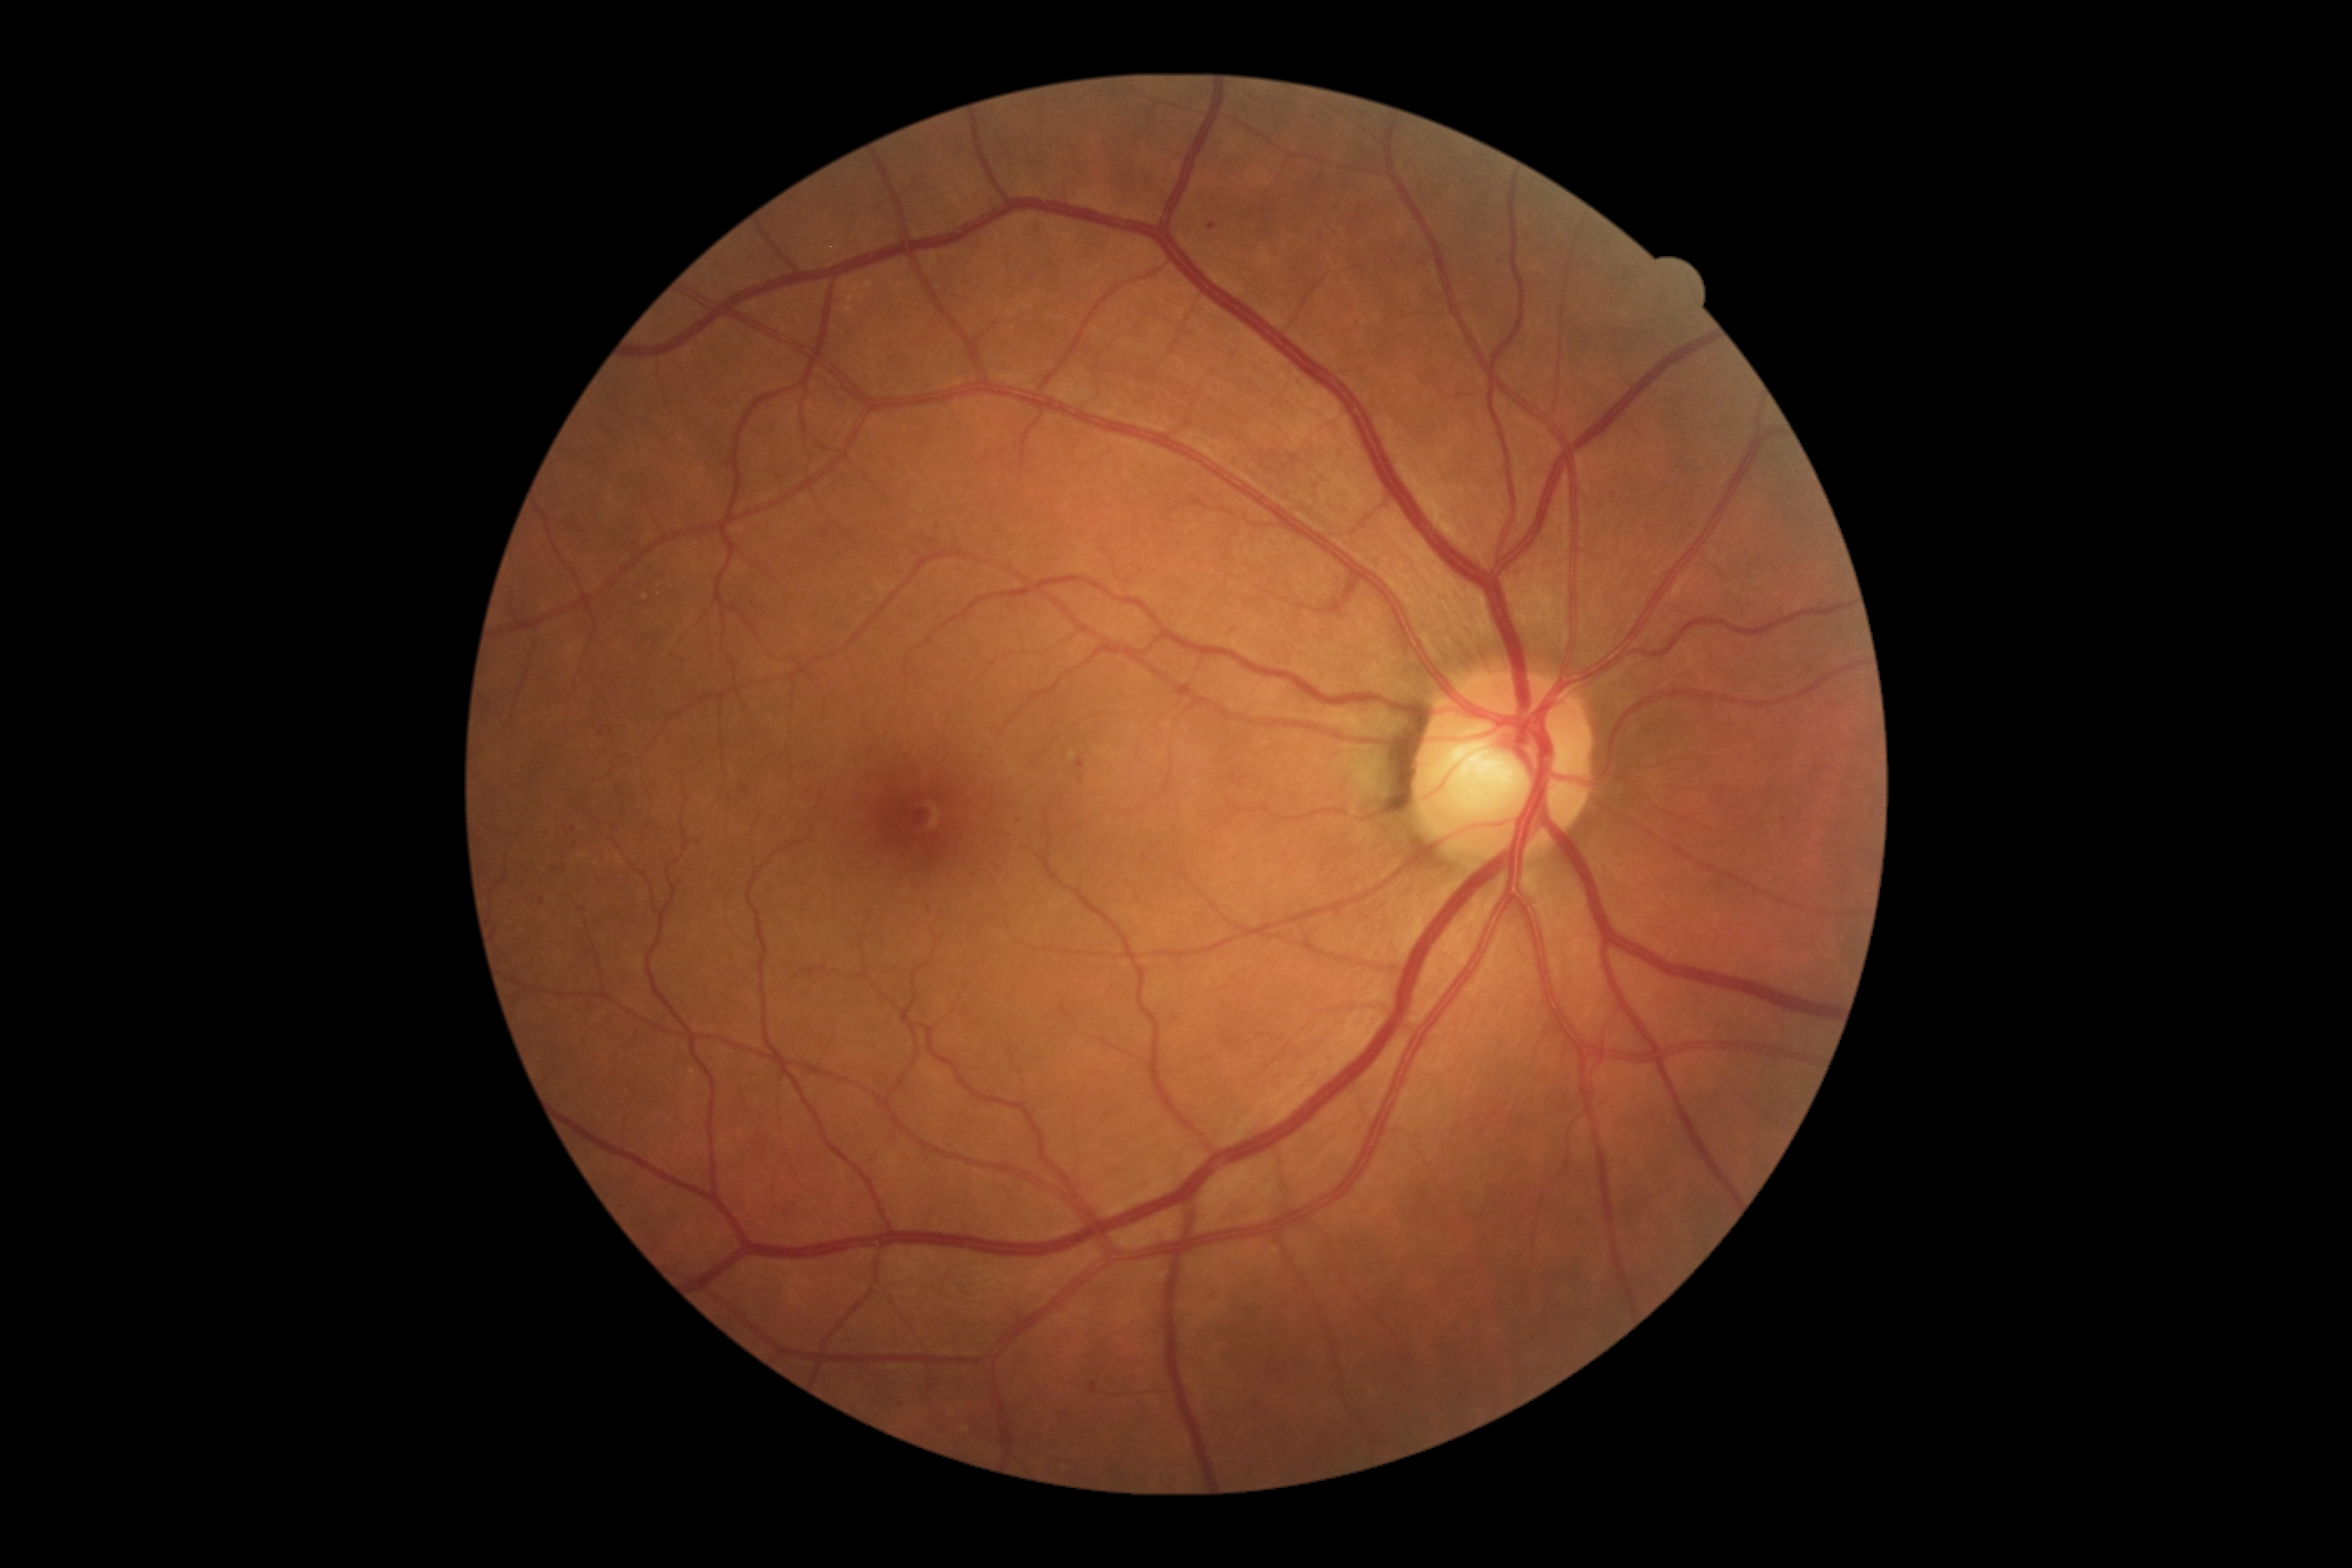 Diabetic retinopathy (DR) is mild non-proliferative diabetic retinopathy (grade 1).